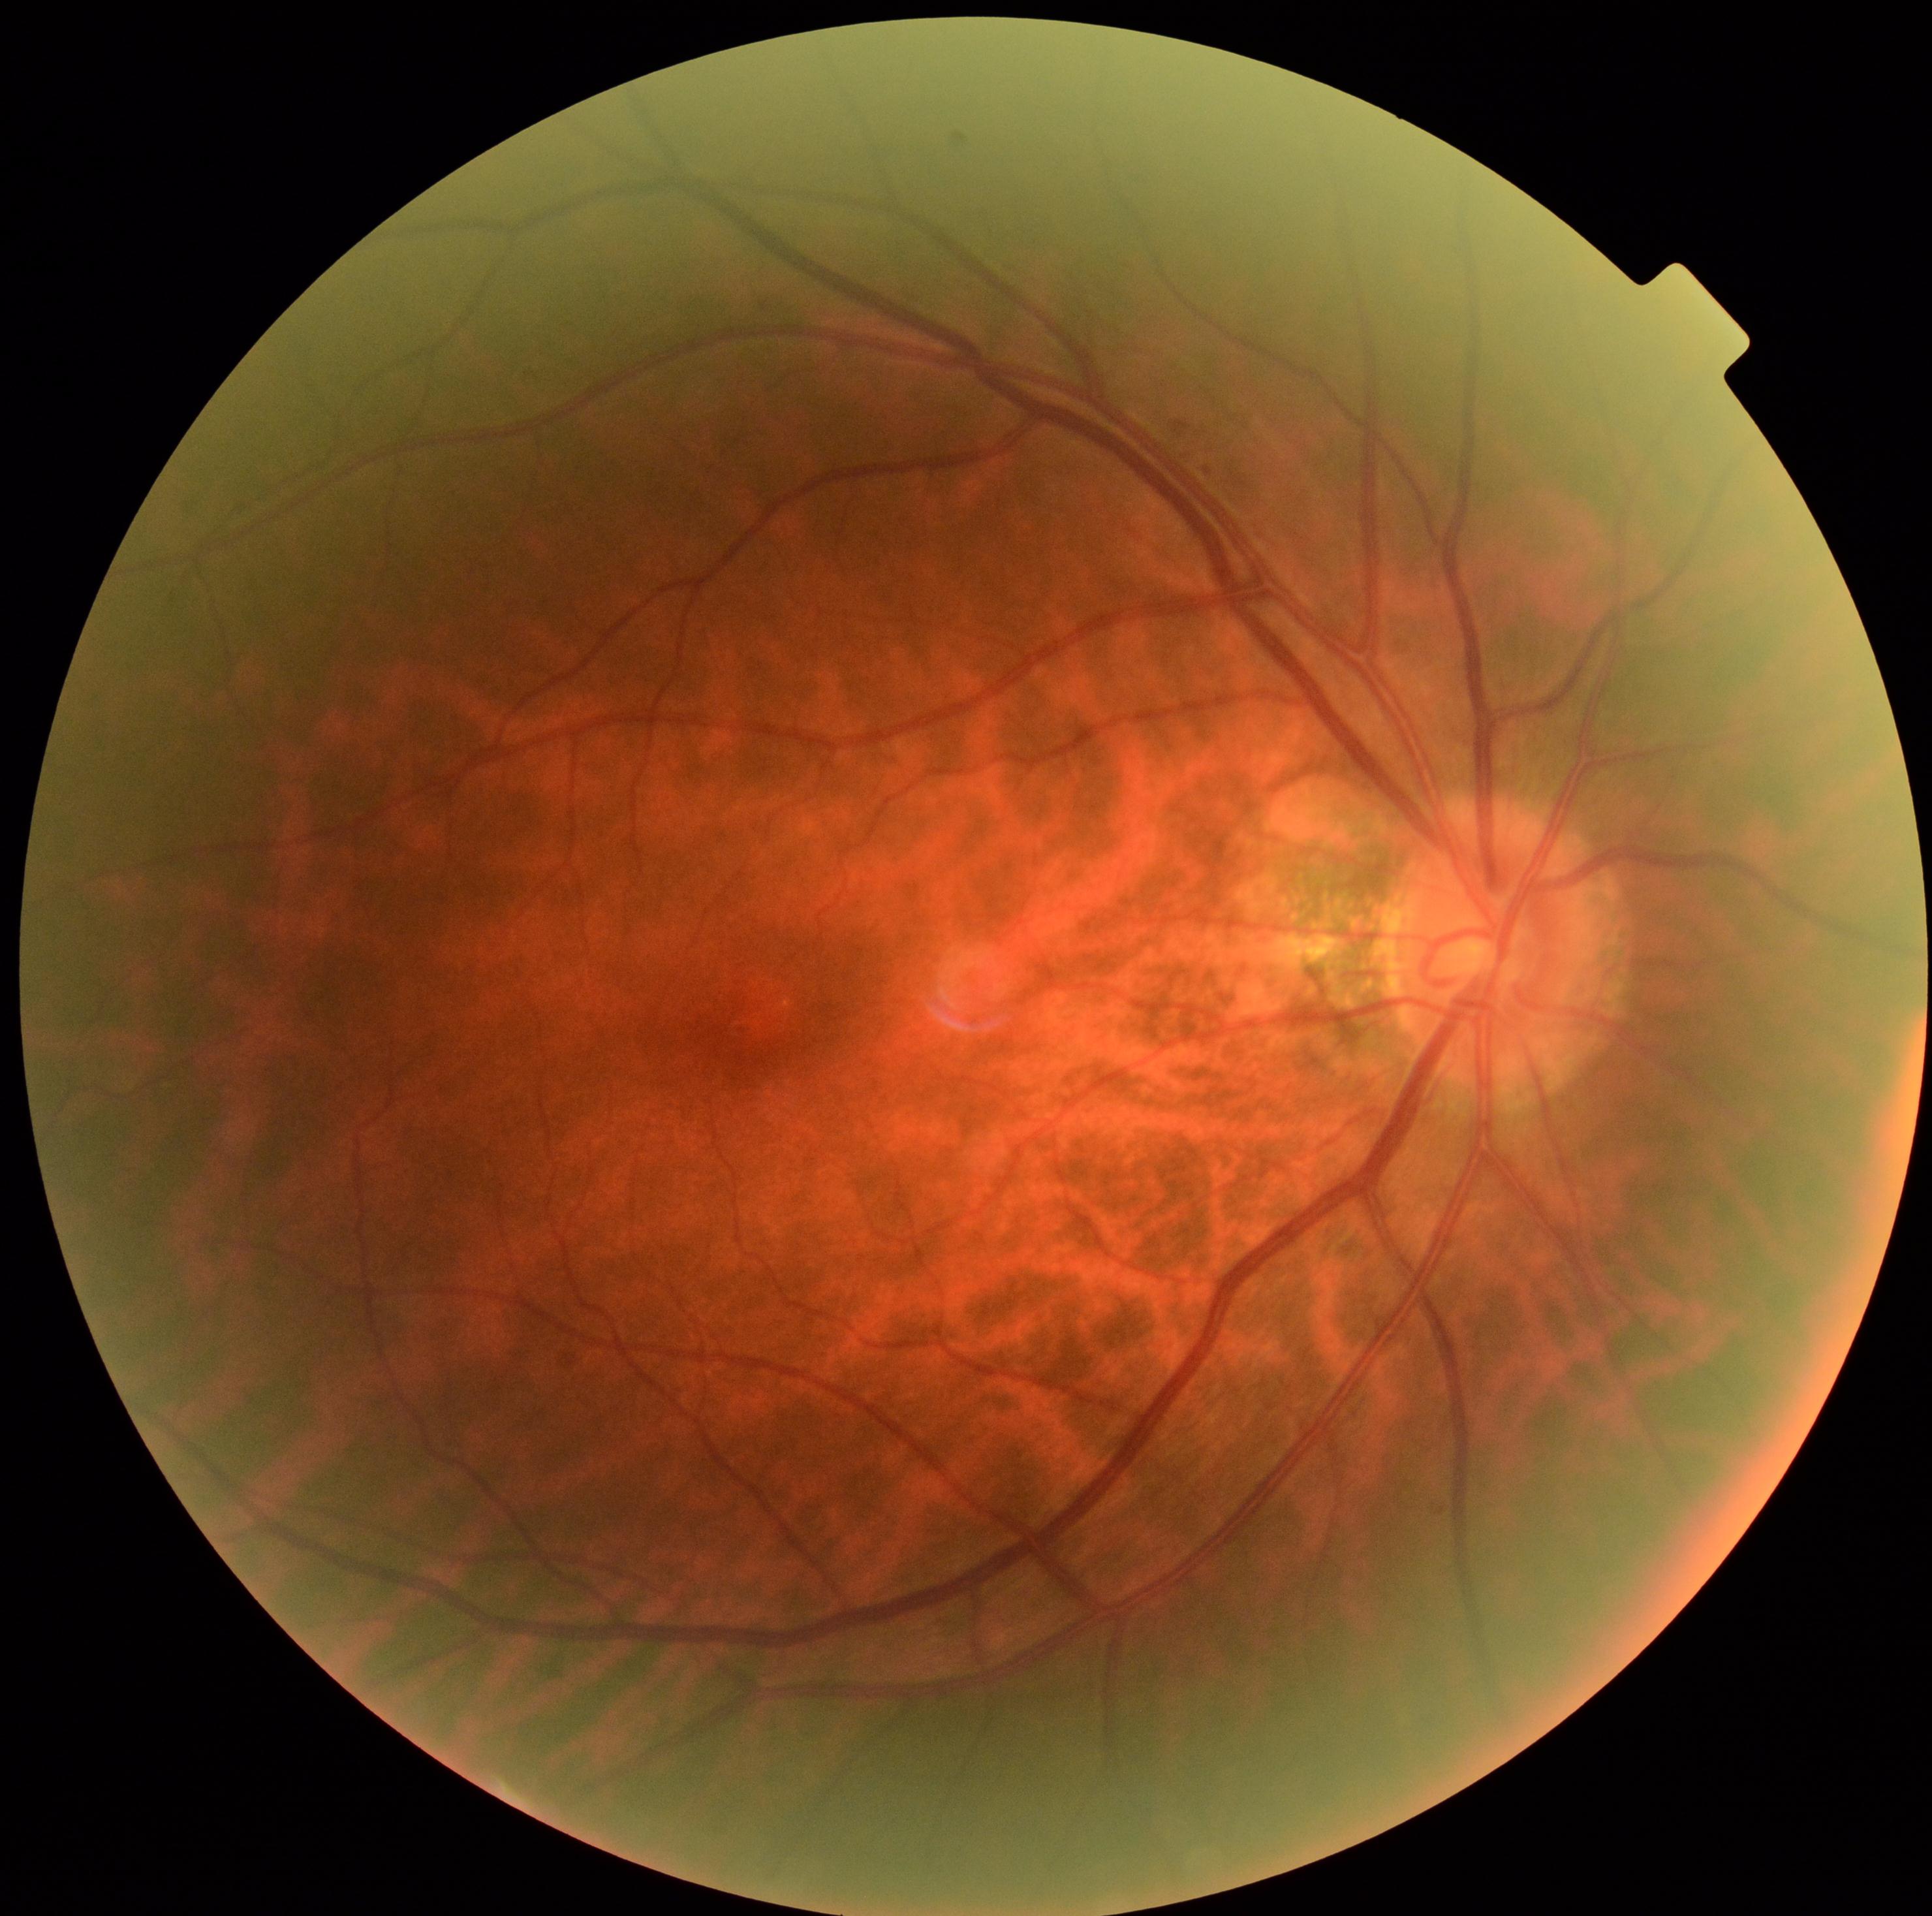
DR stage: grade 2.